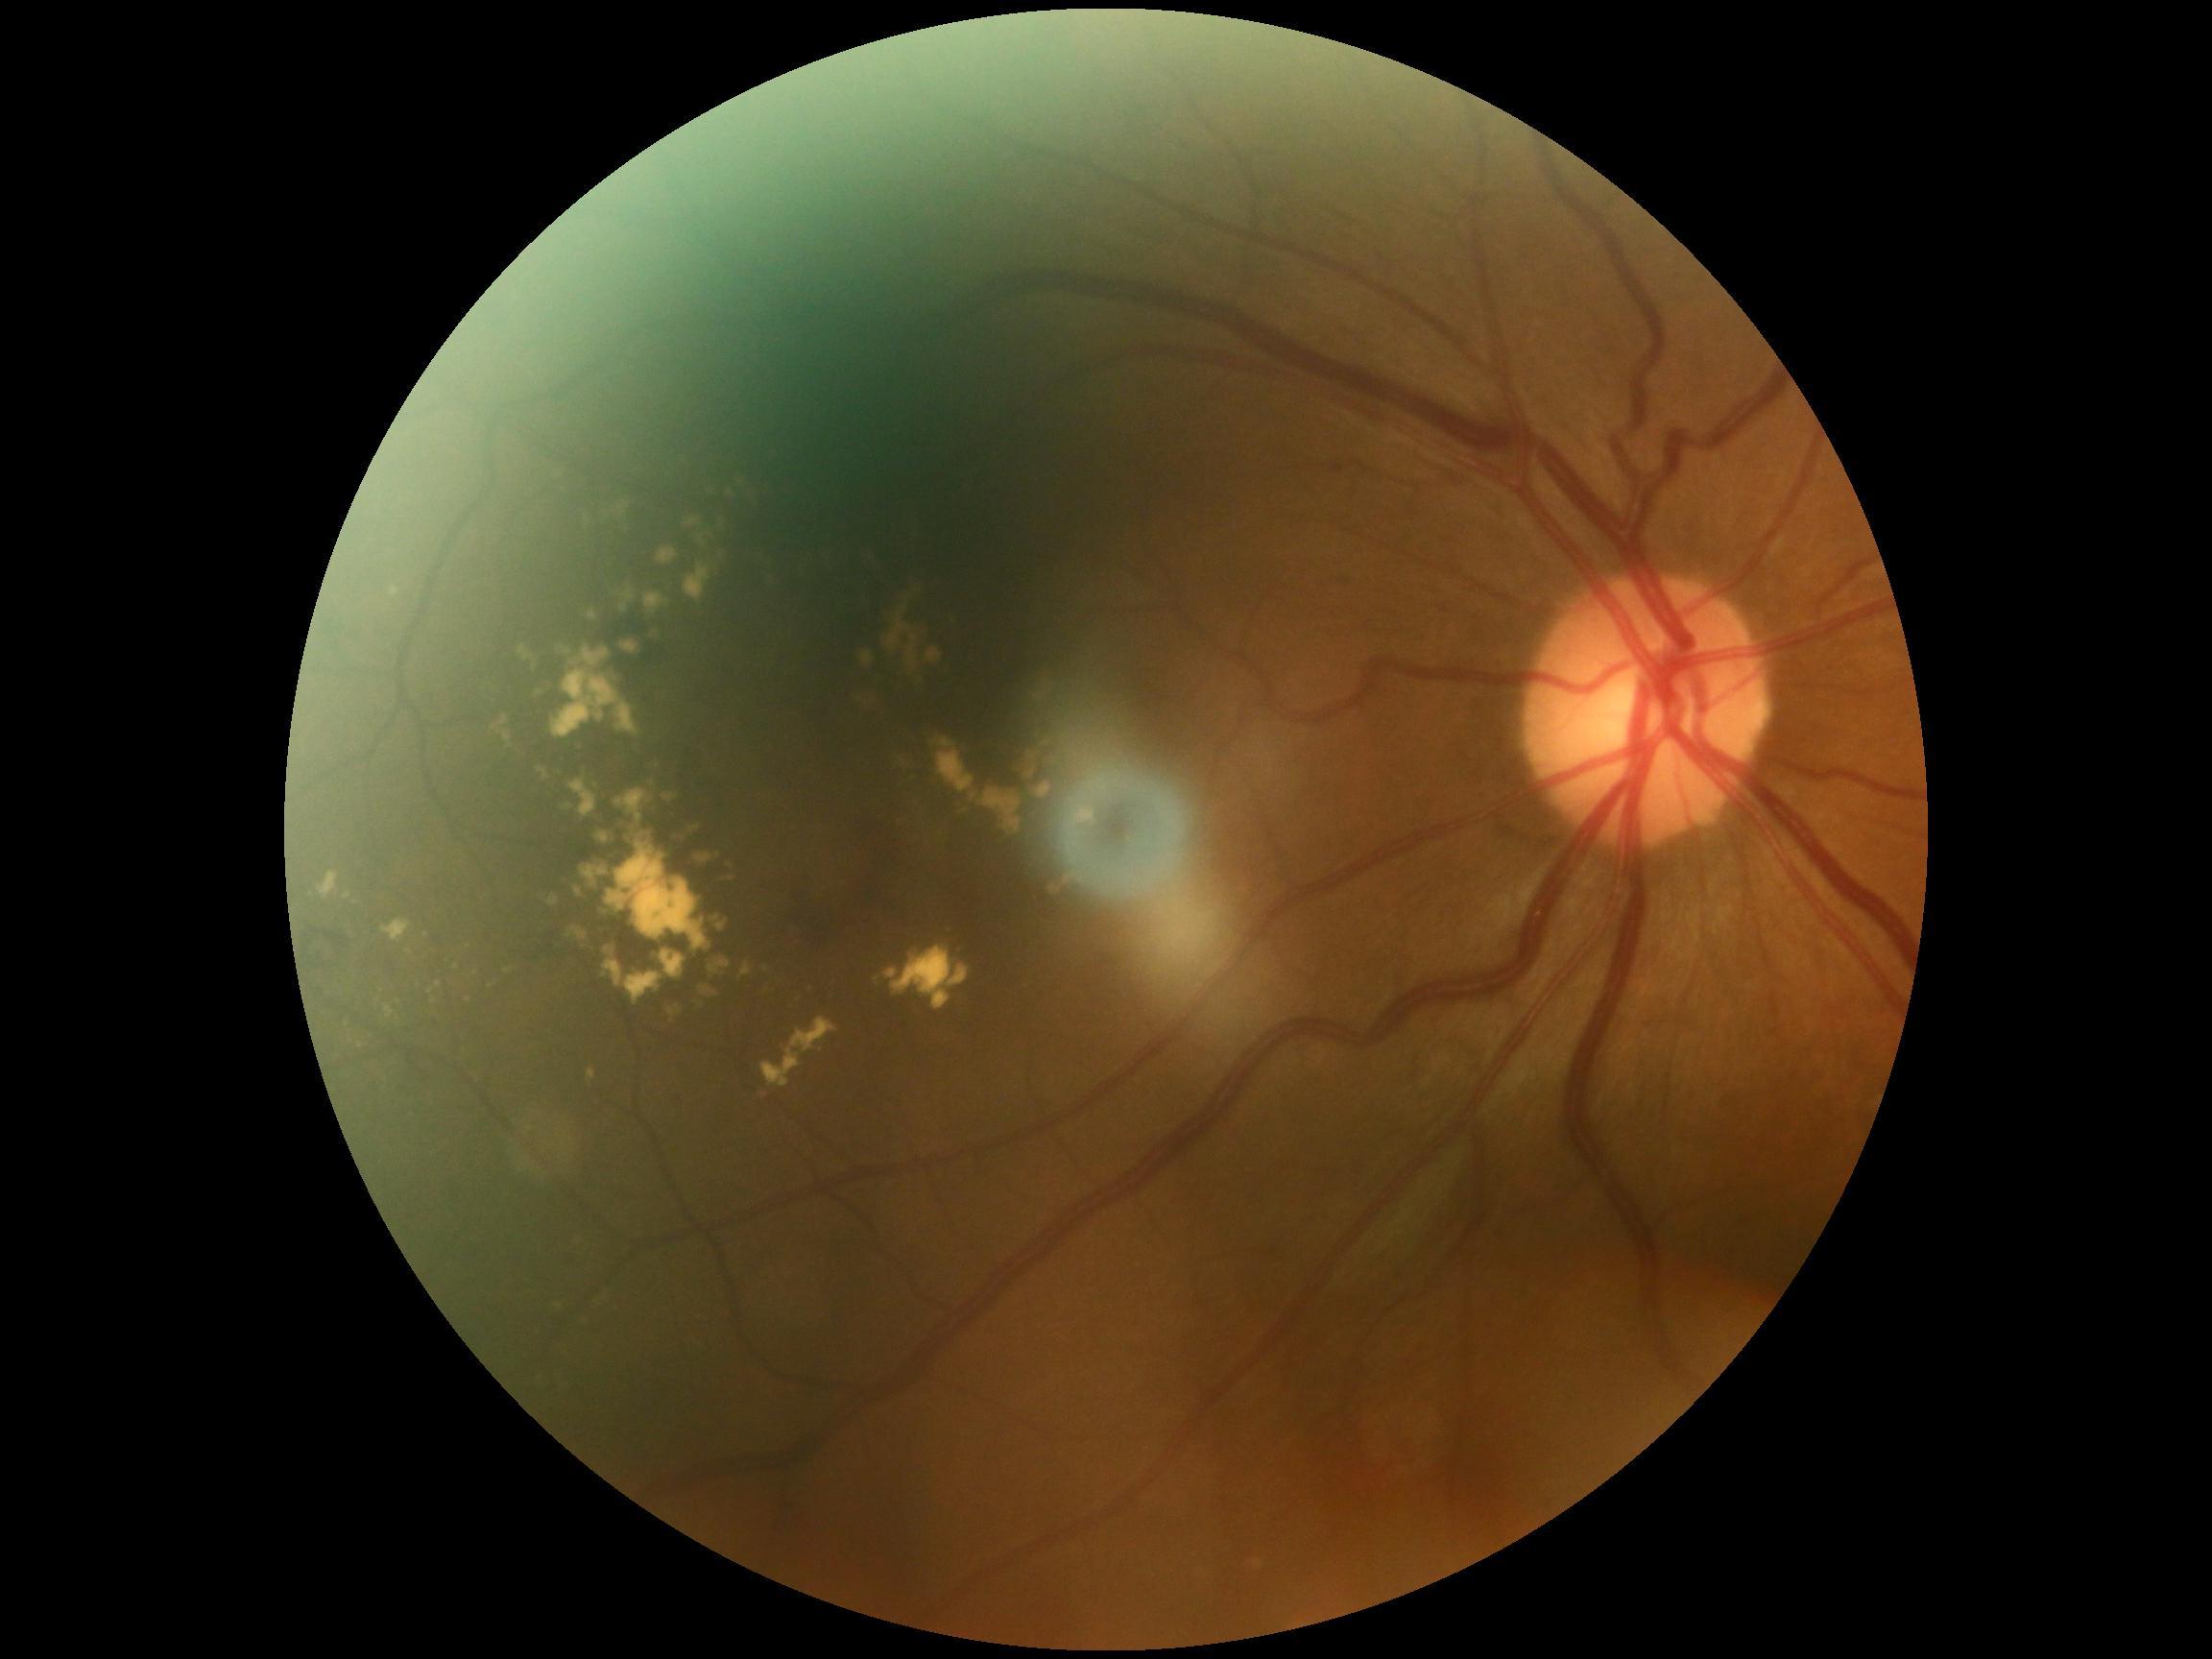
Retinopathy: 2/4.